Image size 2212x1659, FOV: 45 degrees, retinal fundus photograph:
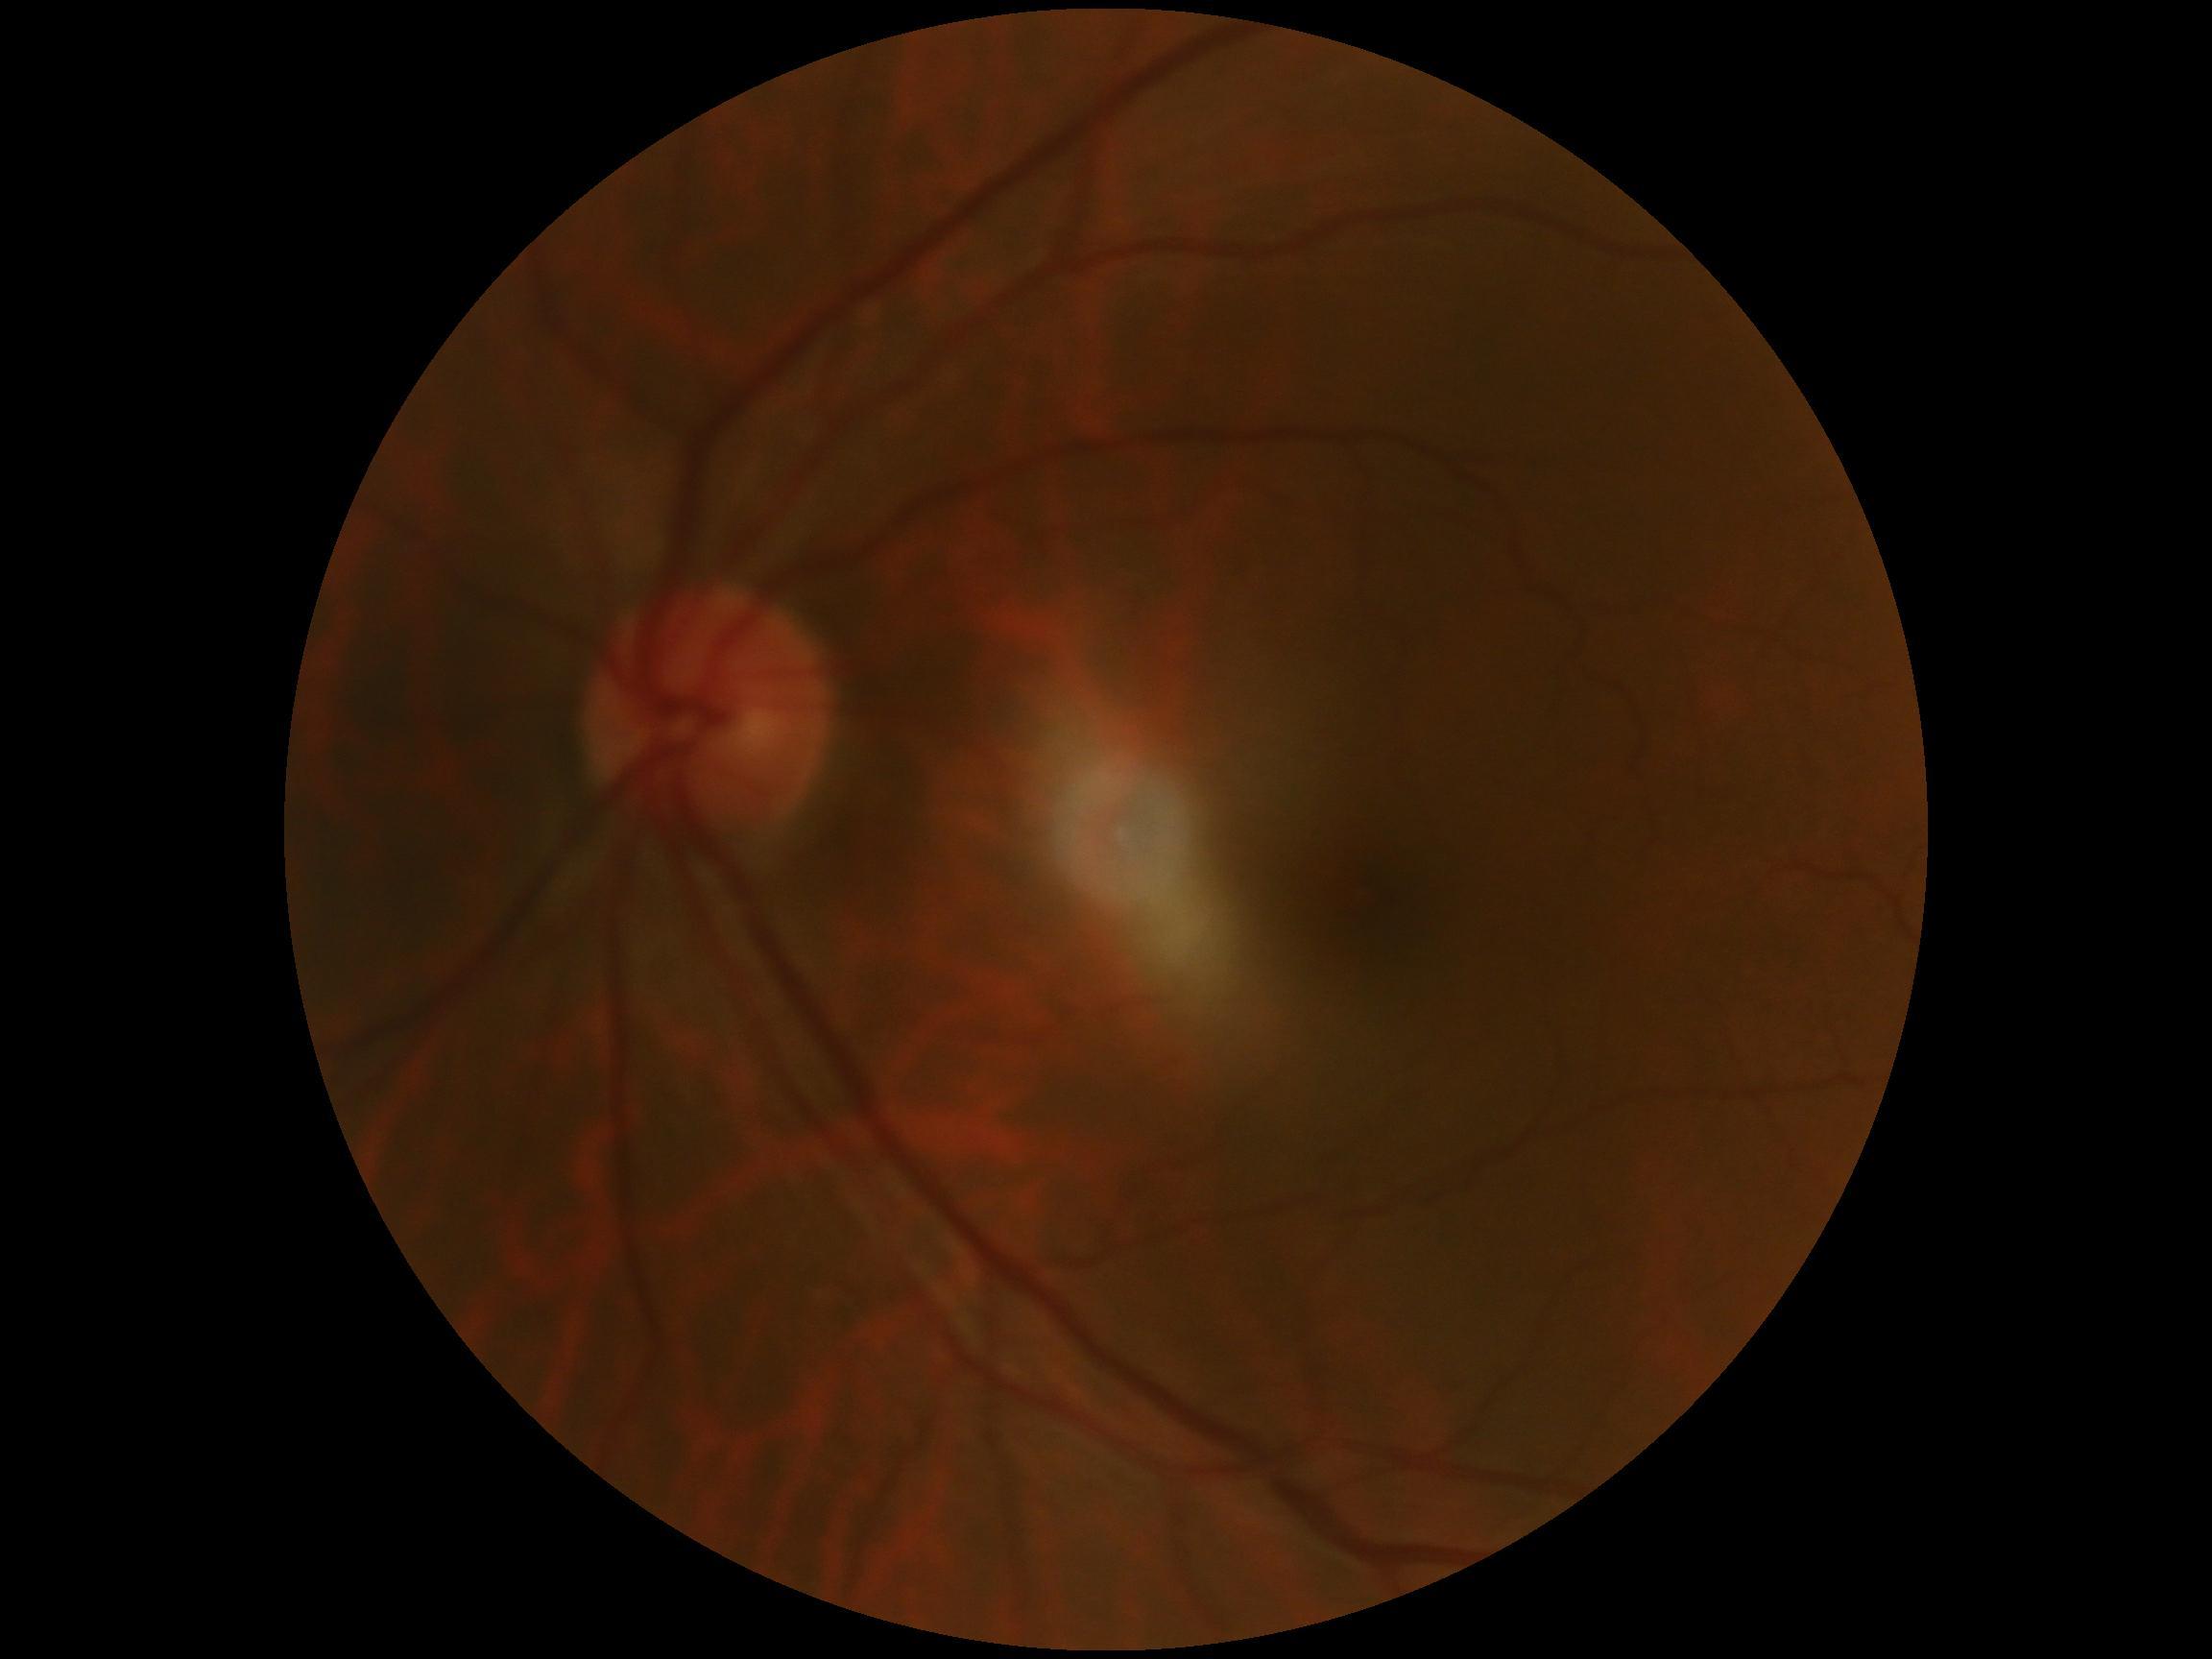

No diabetic retinal disease findings. Diabetic retinopathy severity is 0/4 — no visible signs of diabetic retinopathy.